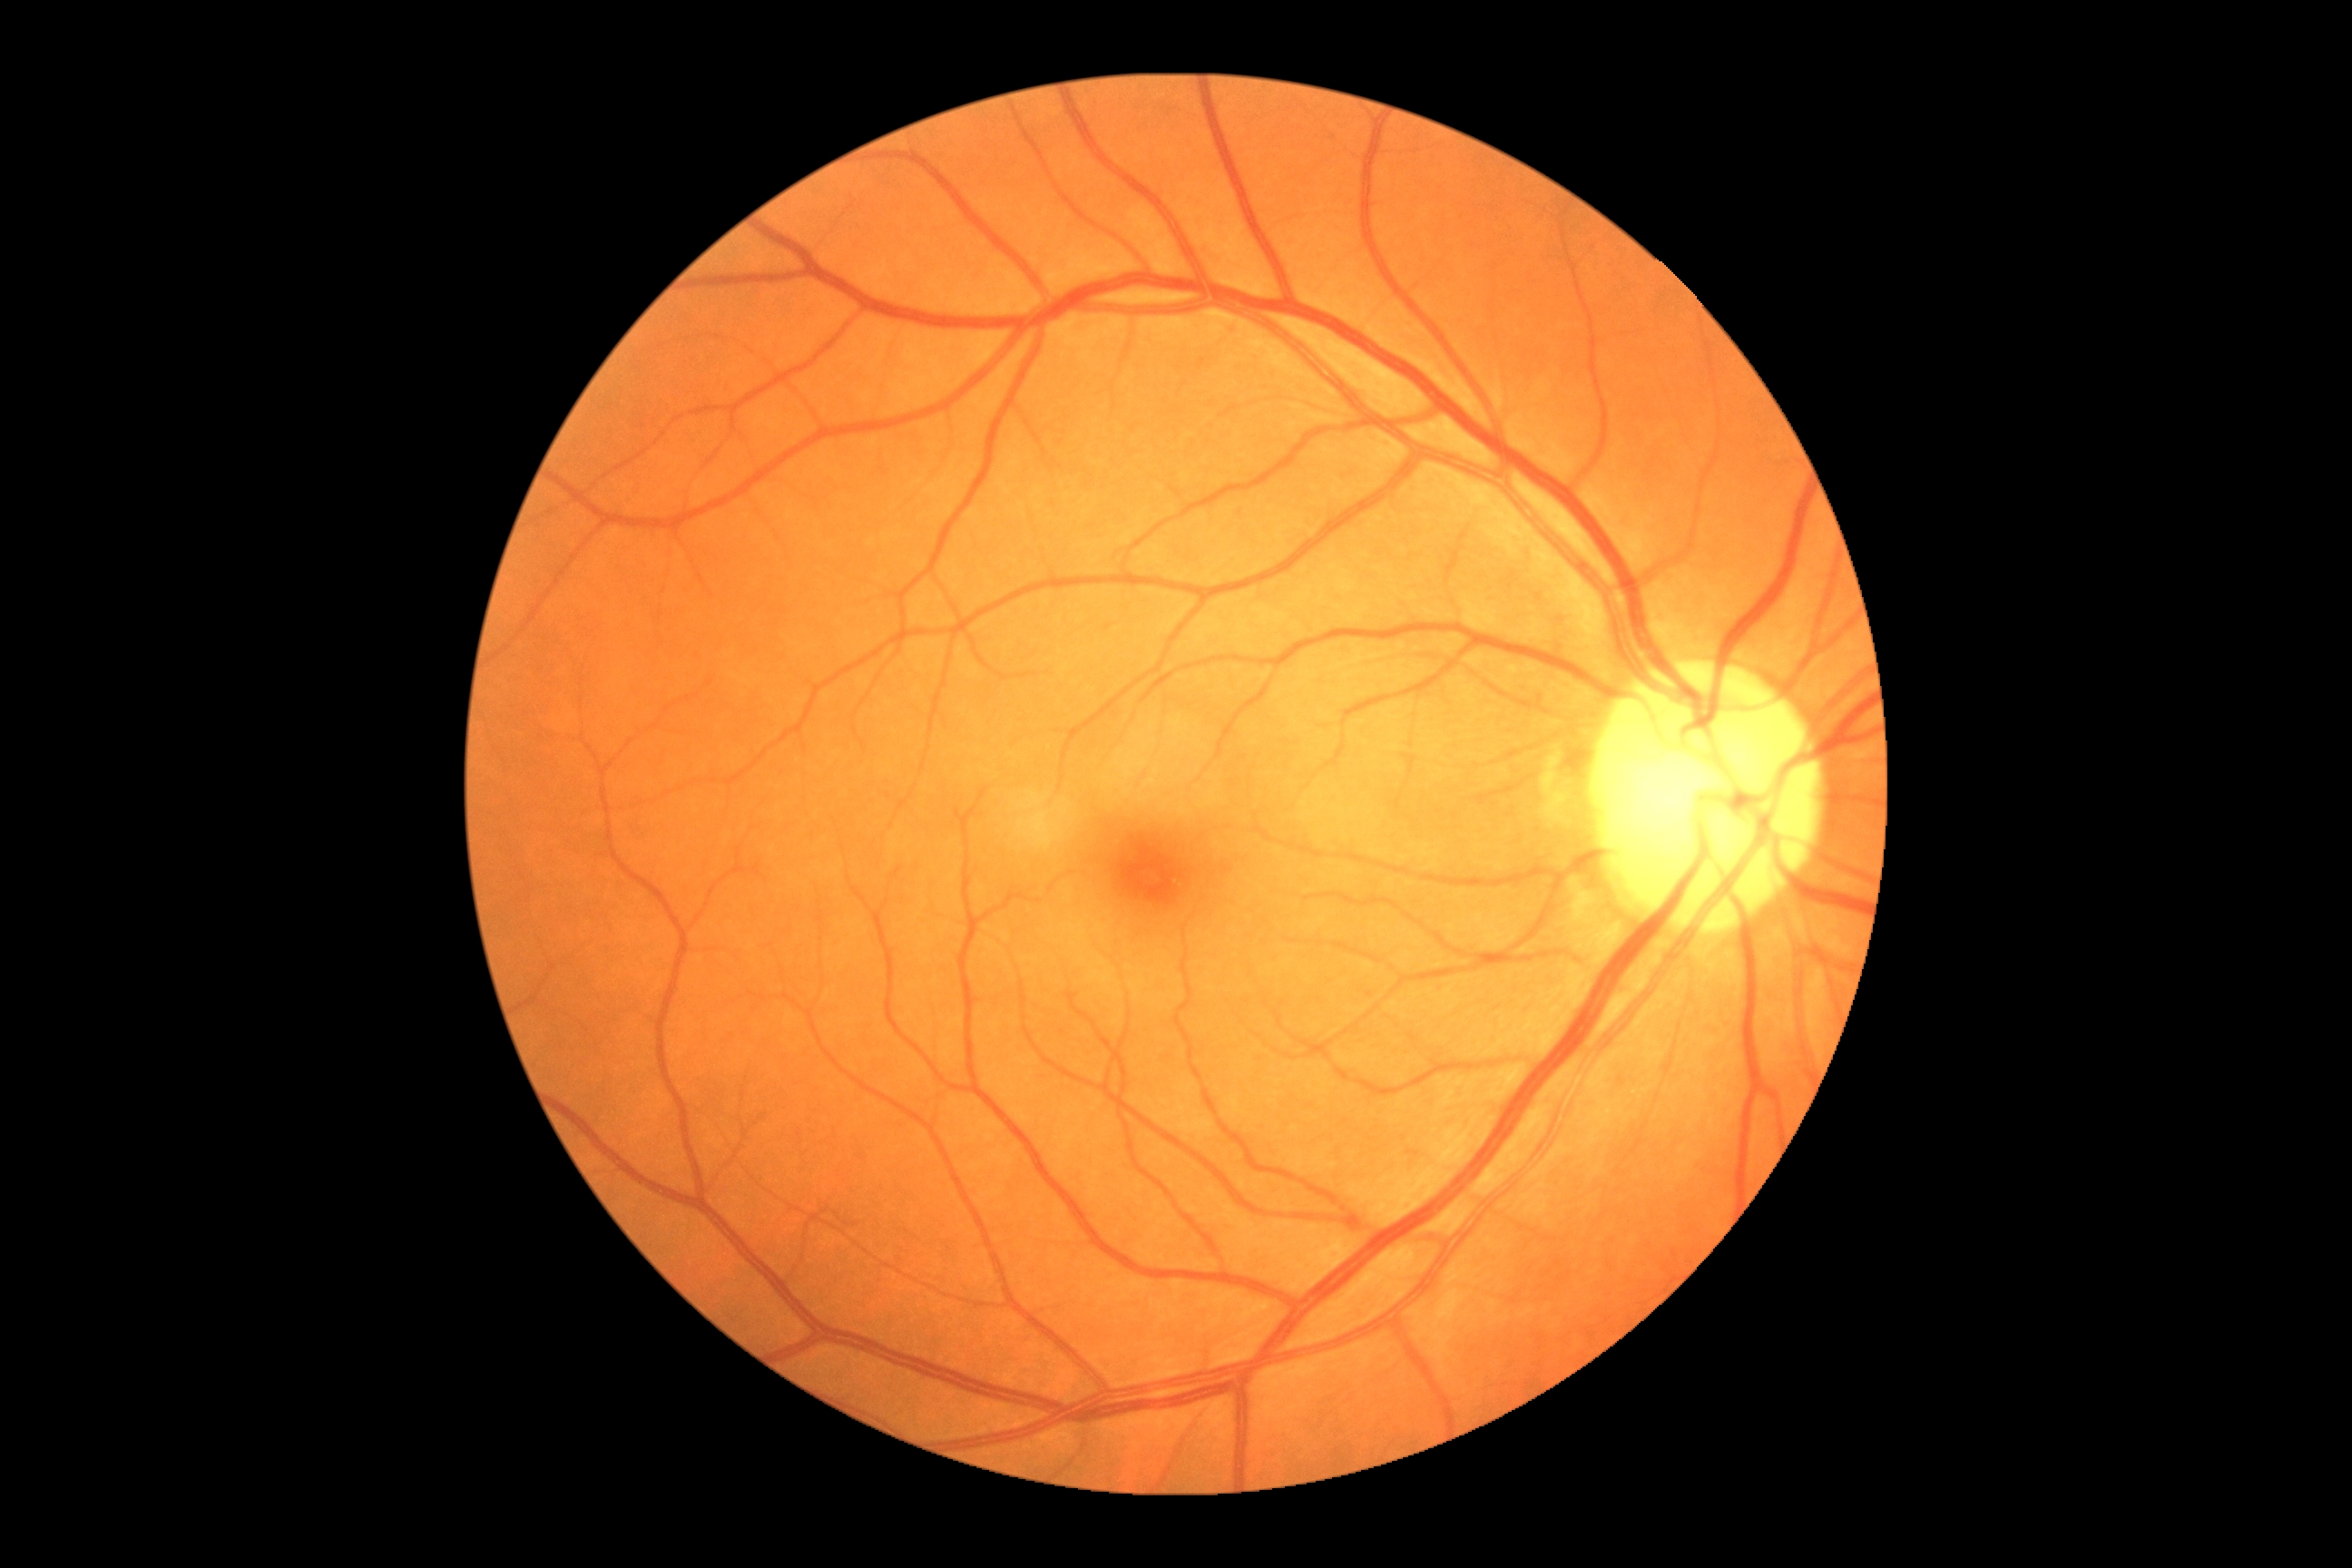

DR stage is grade 0 (no apparent retinopathy).